2212x1659:
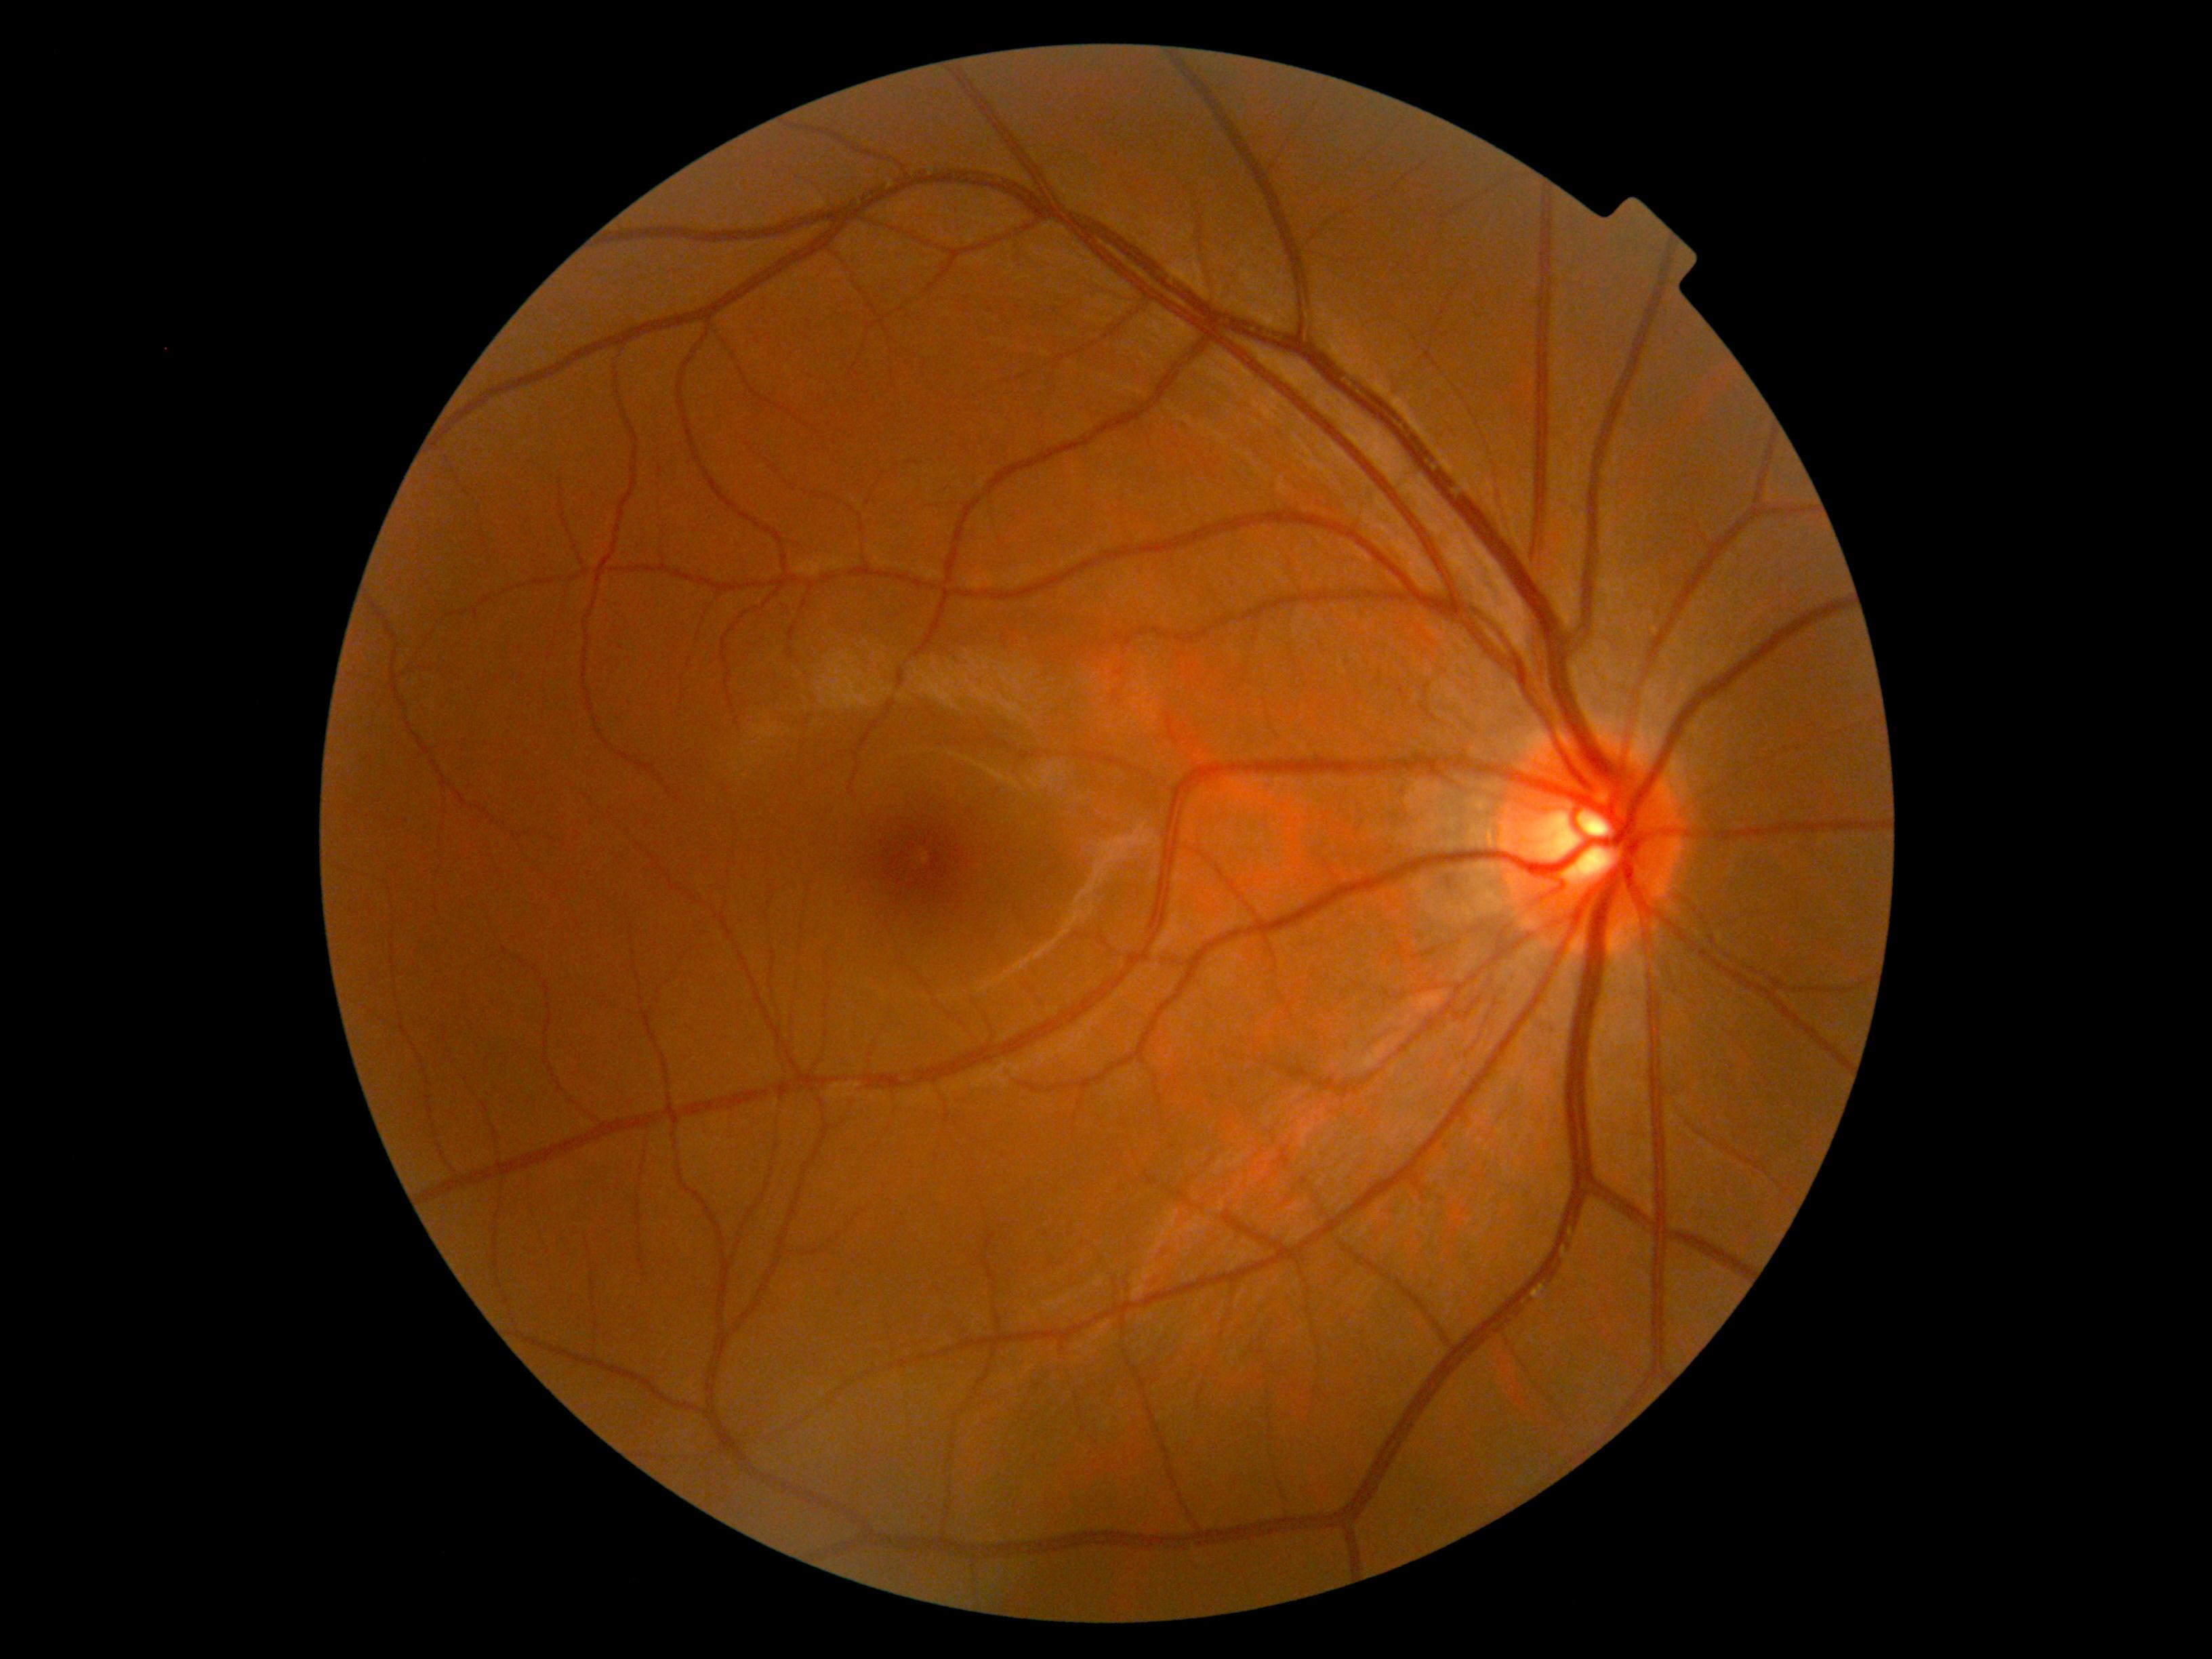
Findings:
• DR — grade 0 (no apparent retinopathy)
• DR impression — no apparent DR